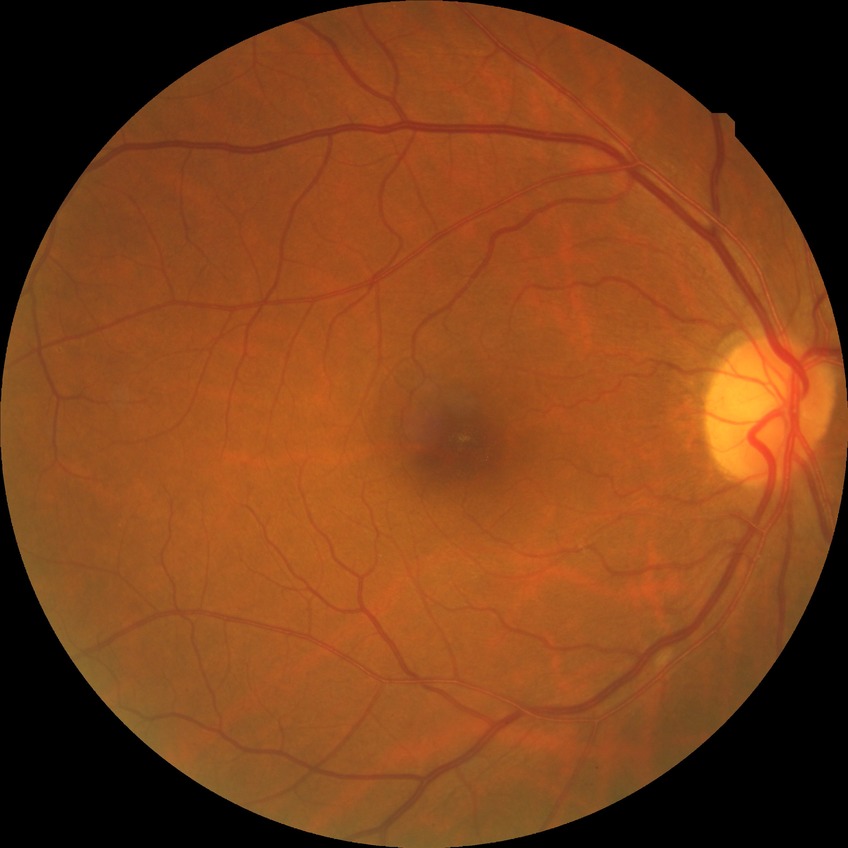

DR grade is SDR.